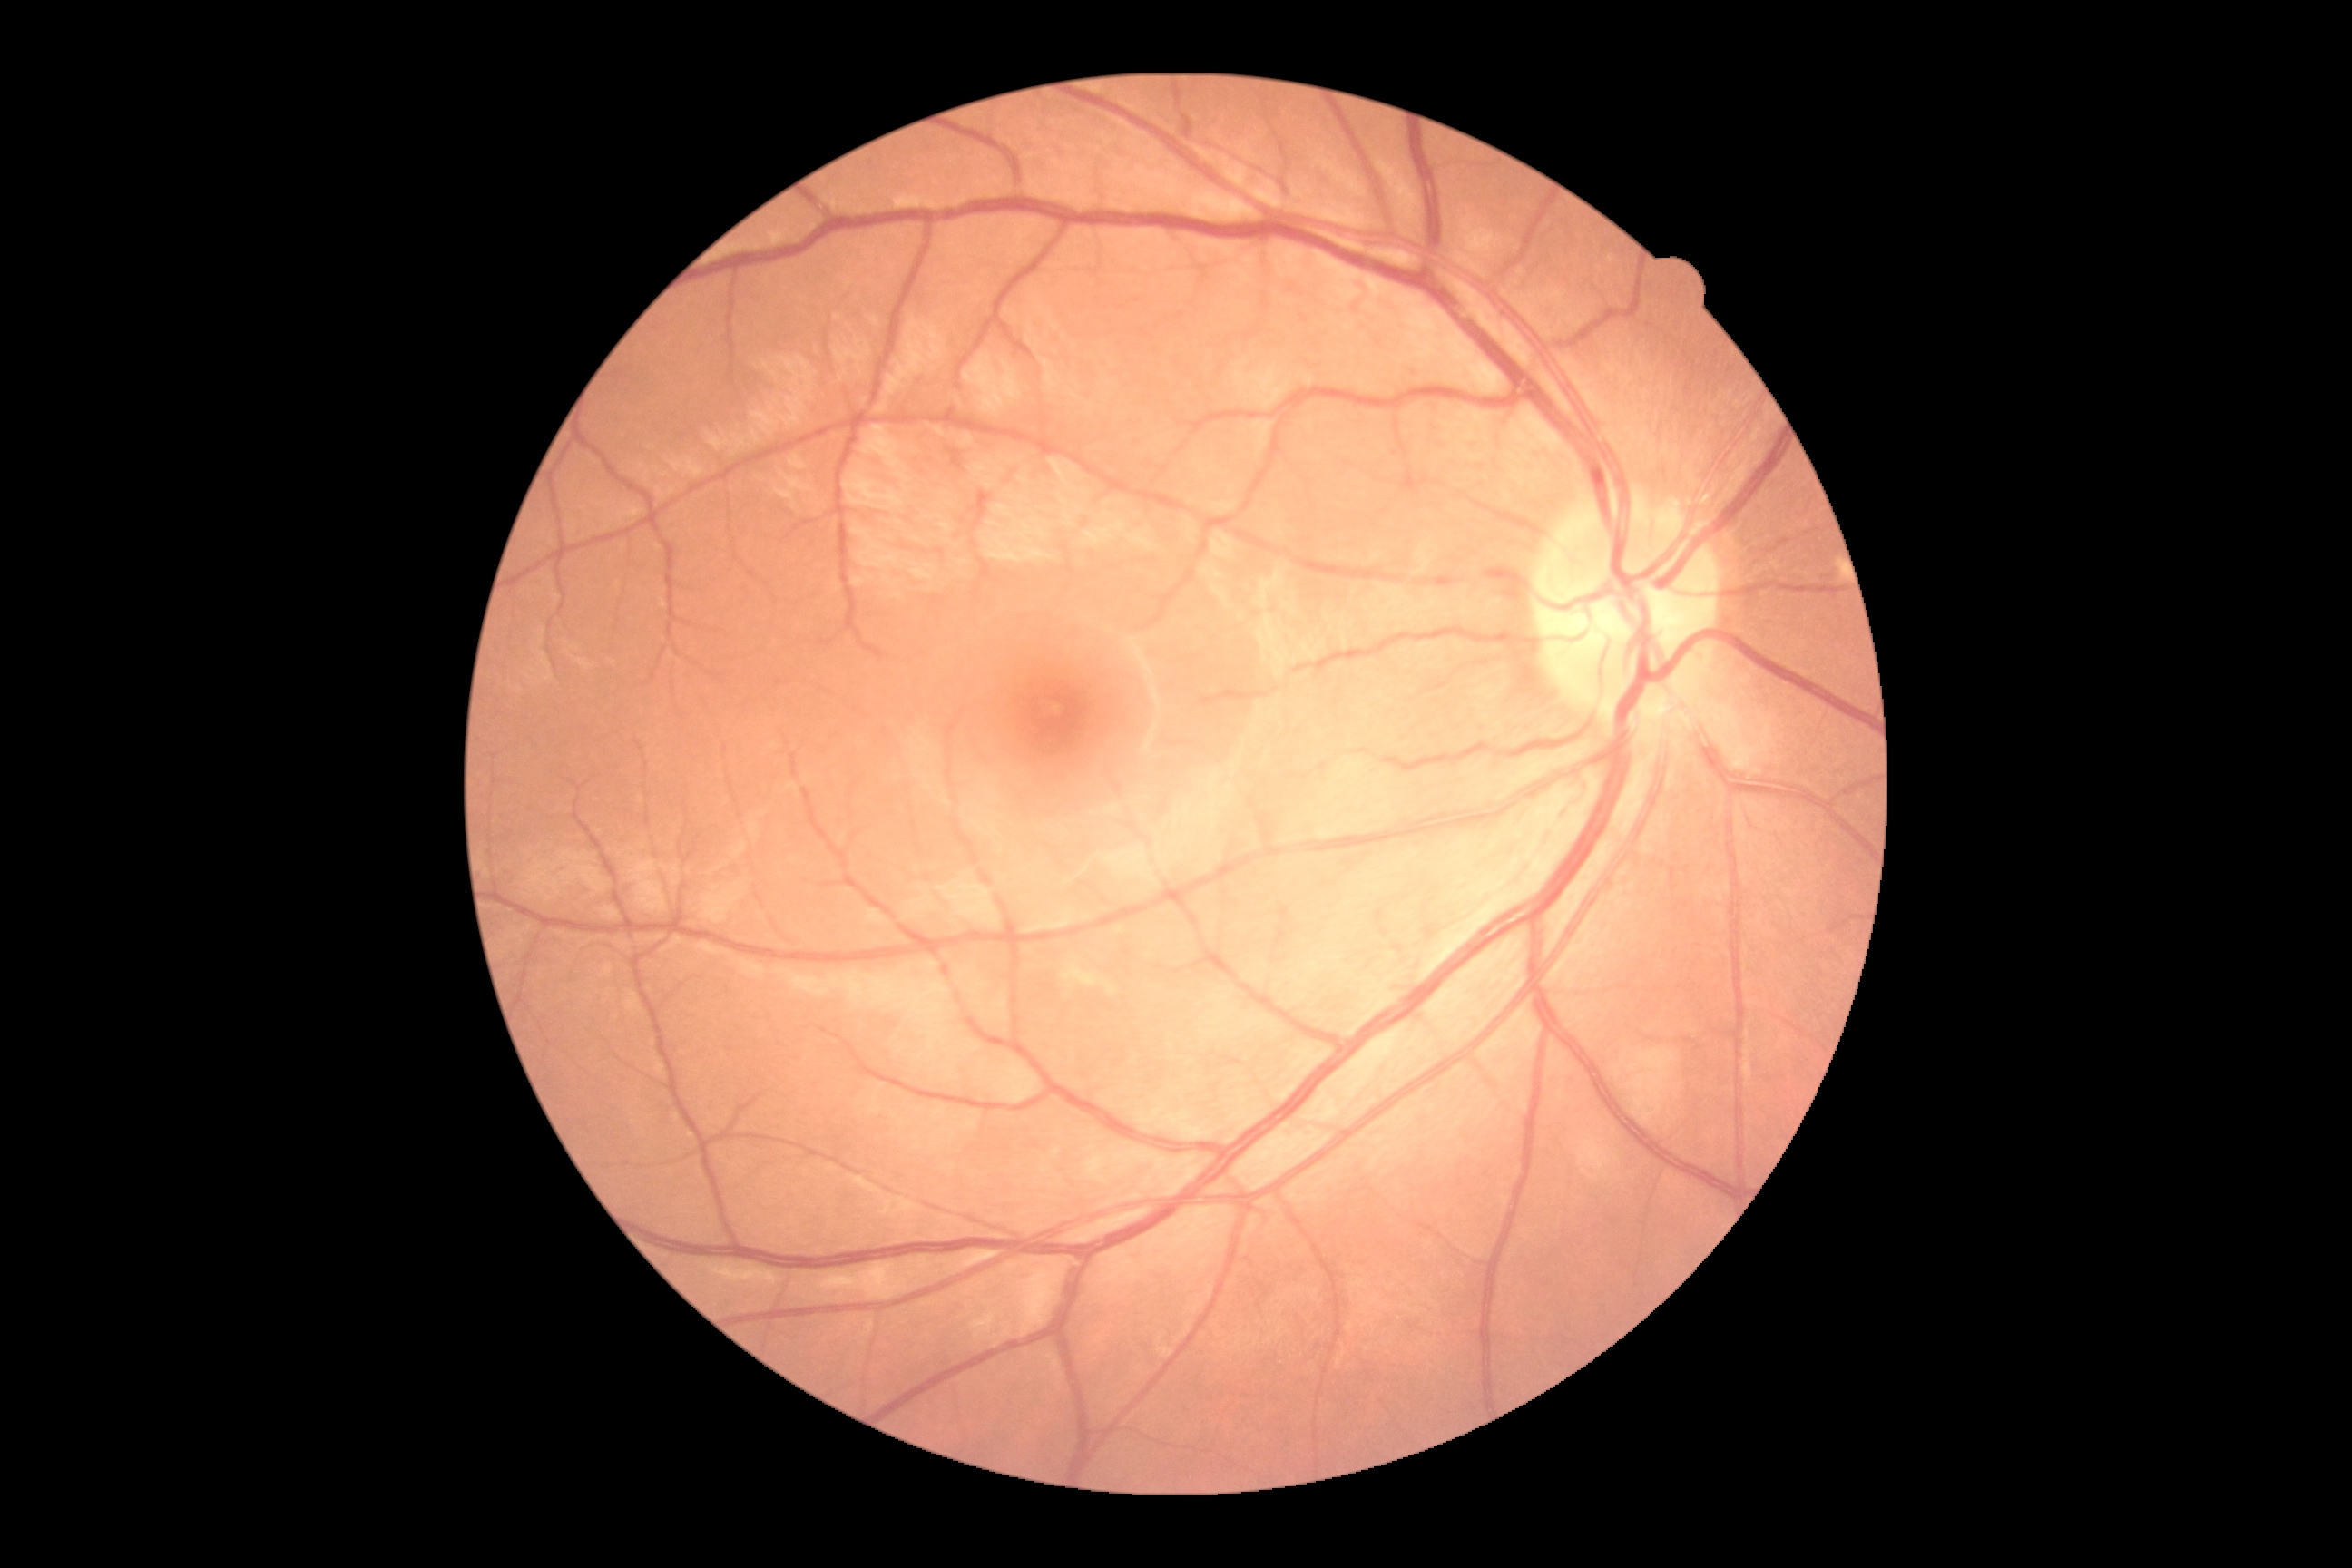
No signs of diabetic retinopathy. Retinopathy grade: no apparent retinopathy (0).